Fundus photograph cropped around the optic nerve head: 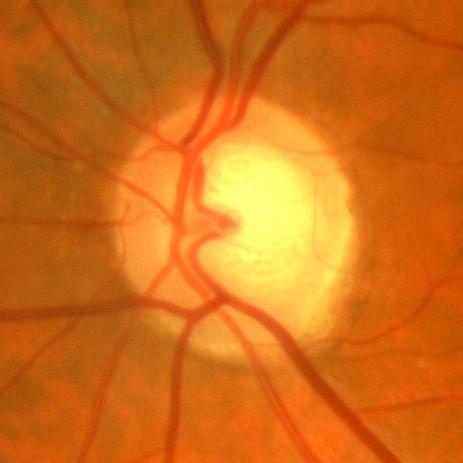

Impression = no glaucomatous optic neuropathy.